CFP.
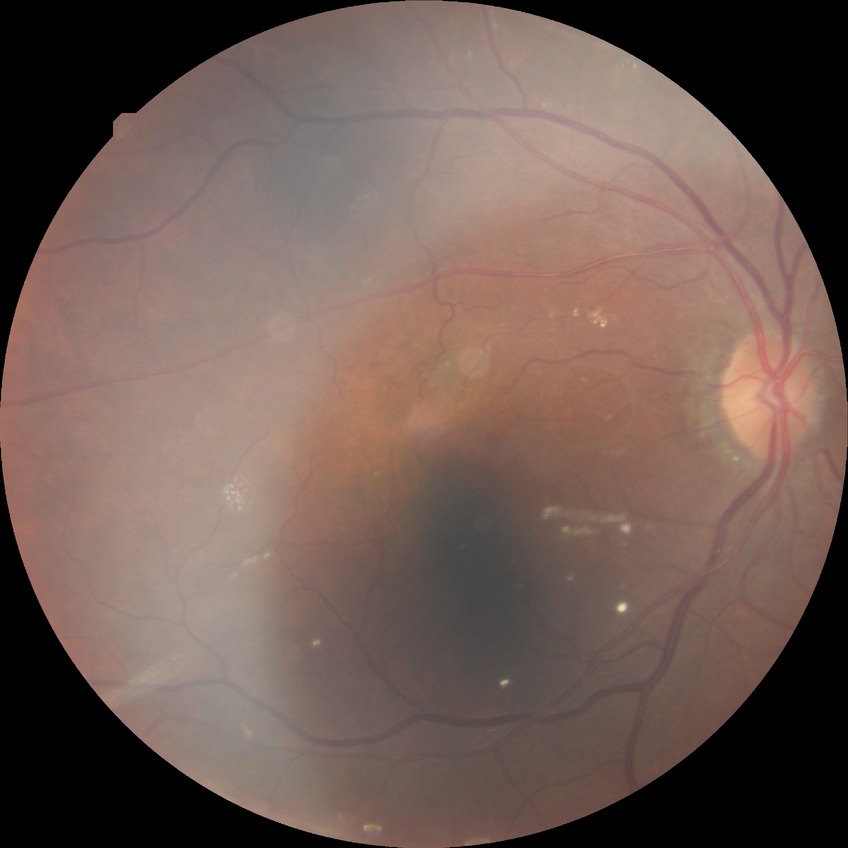

Retinopathy stage is simple diabetic retinopathy.